45° FOV. 848x848px:
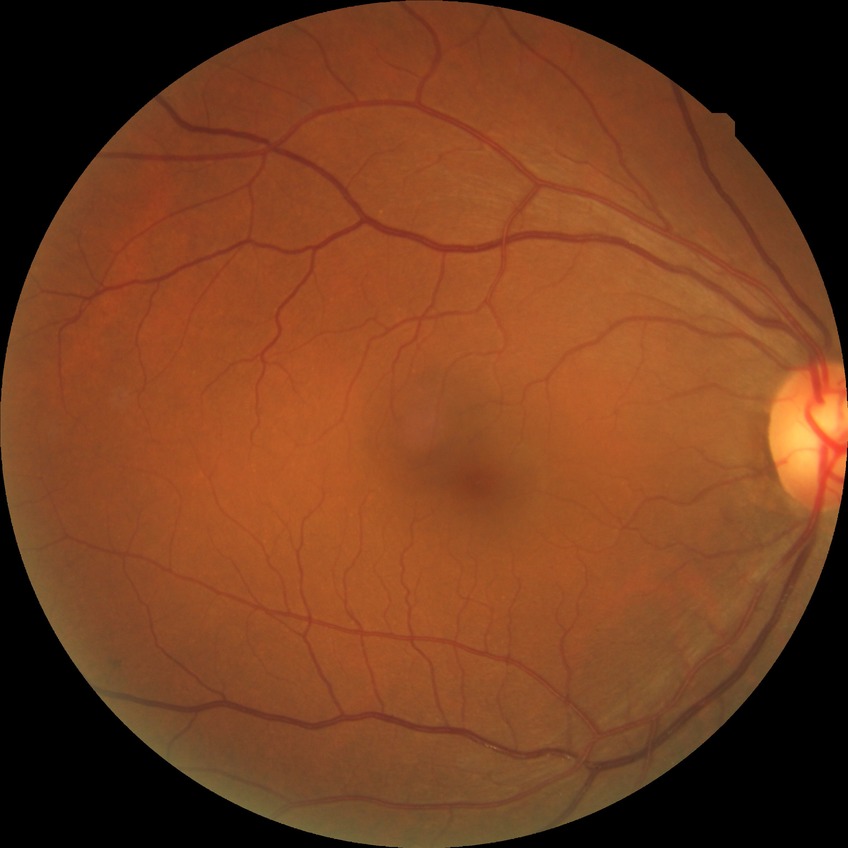 Diabetic retinopathy grade: no diabetic retinopathy.